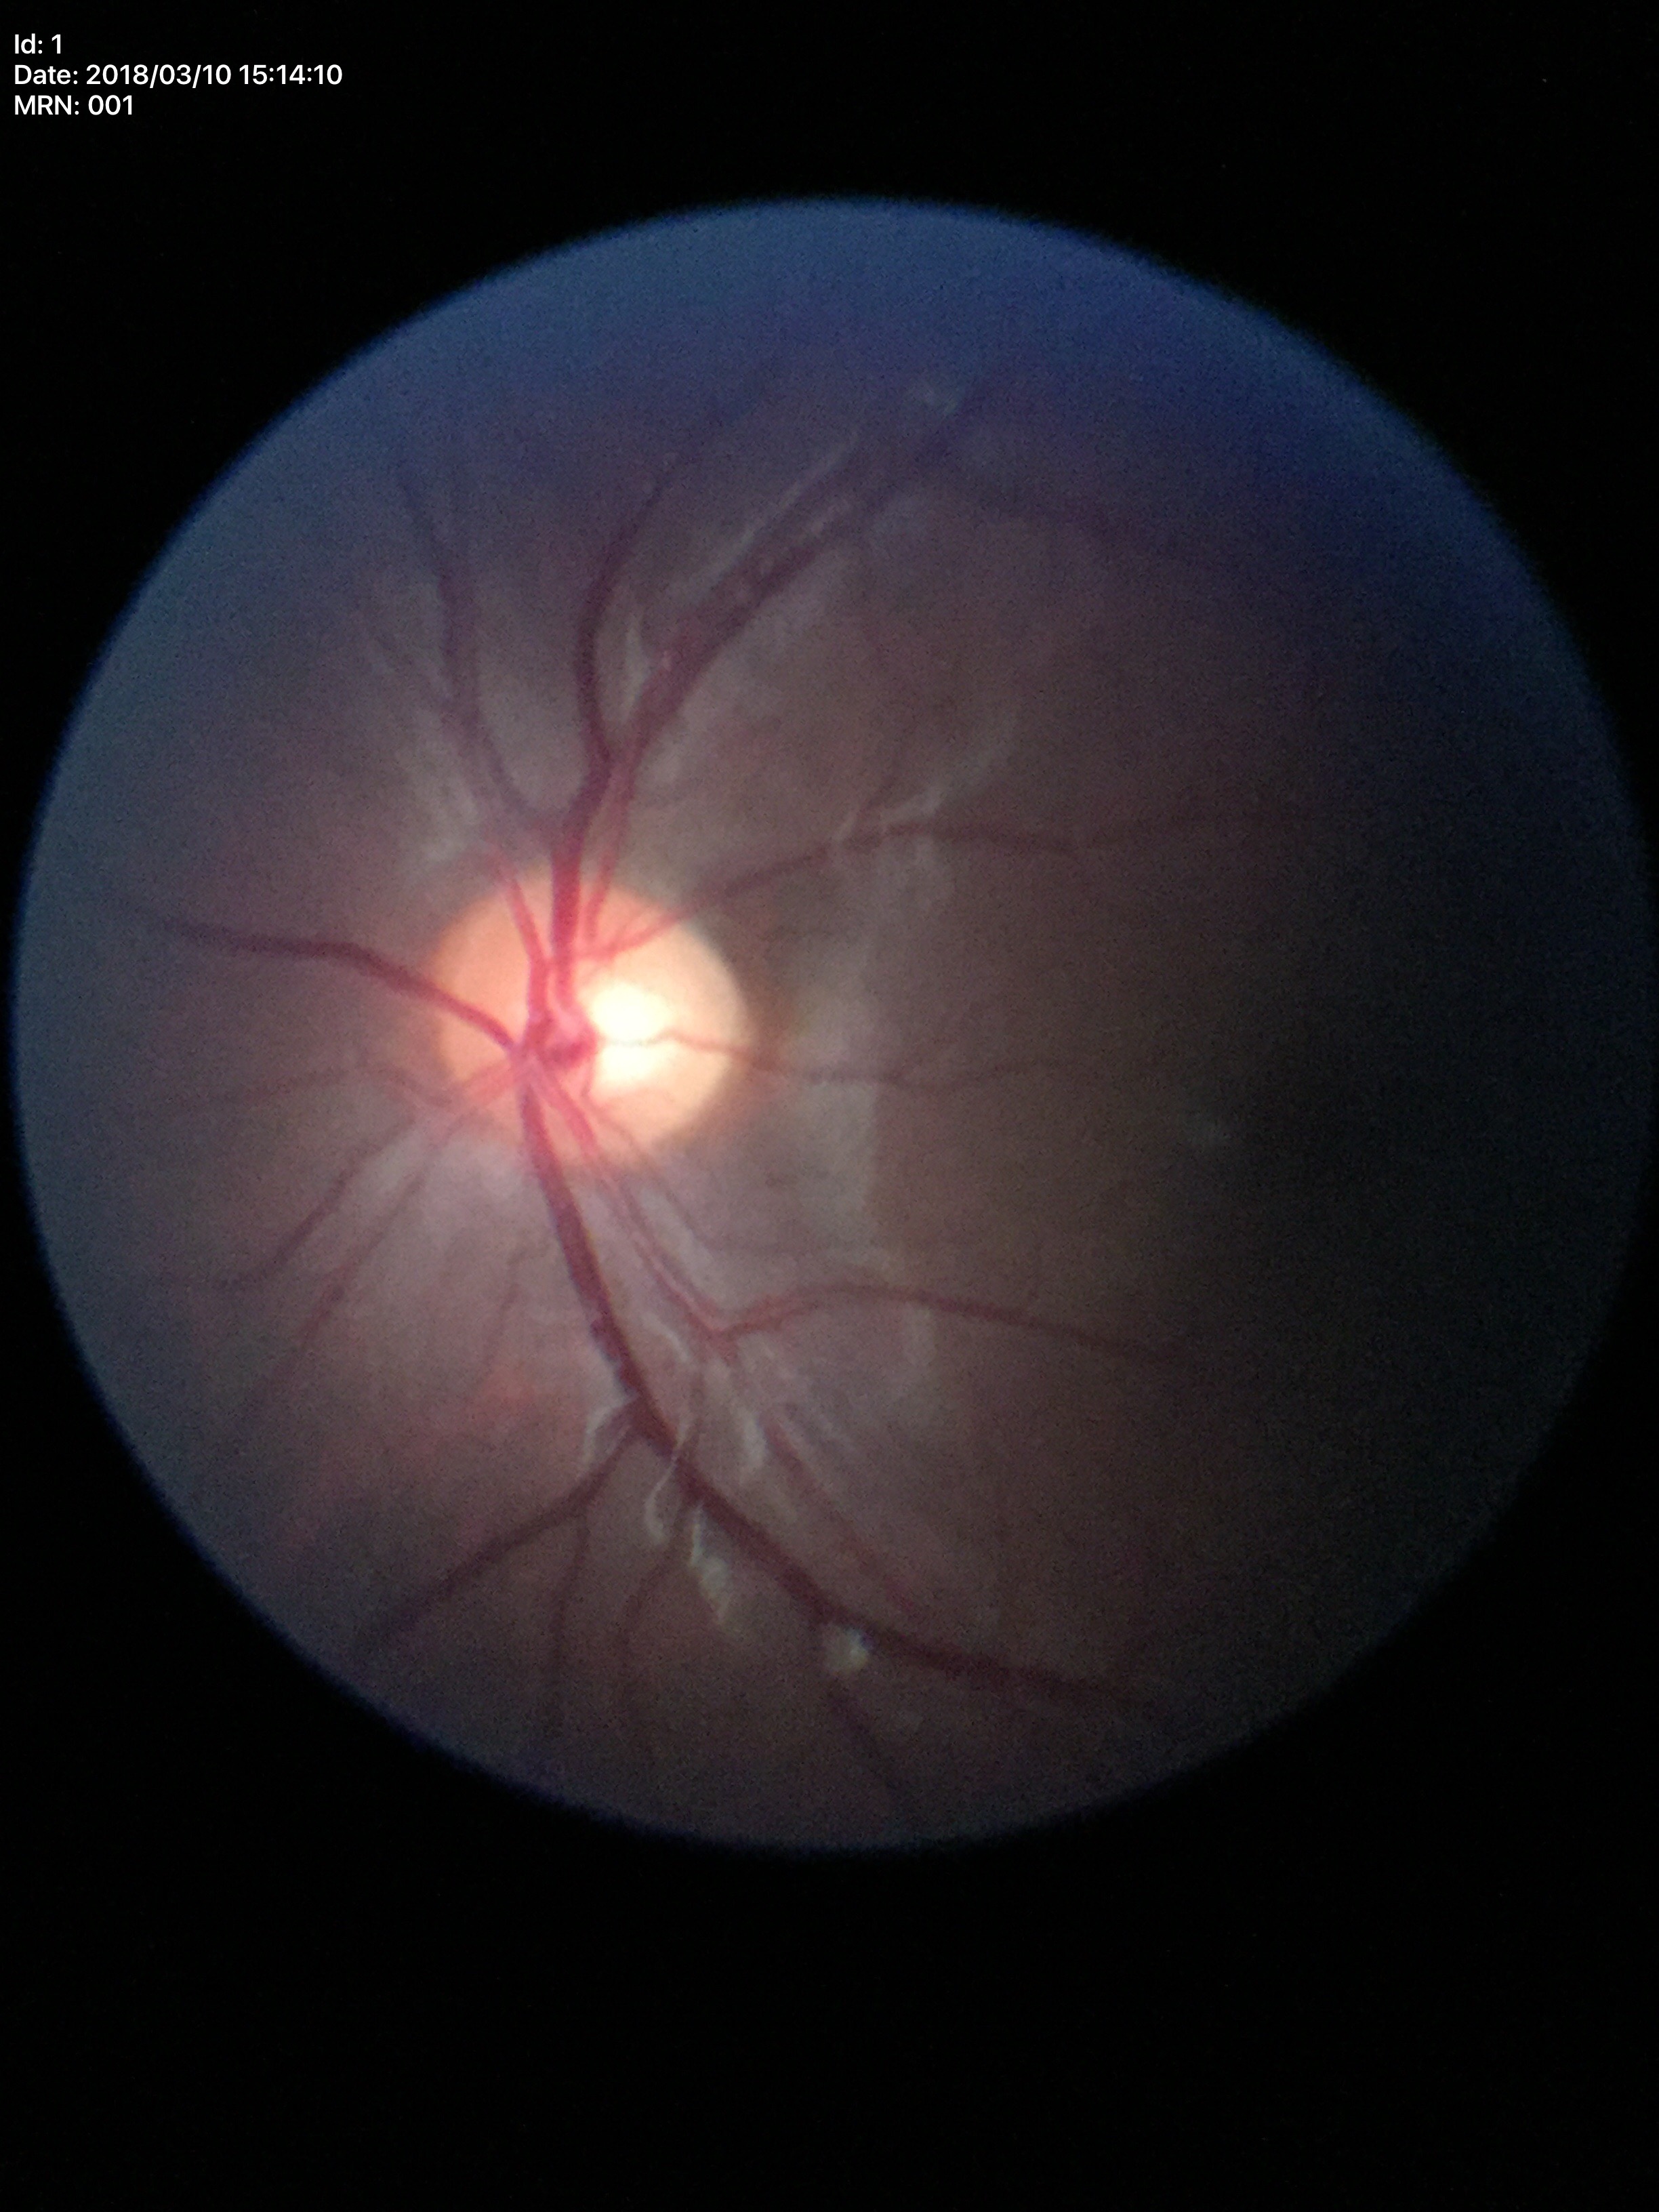
Glaucoma evaluation: negative; vertical cup-to-disc ratio (VCDR): 0.51.